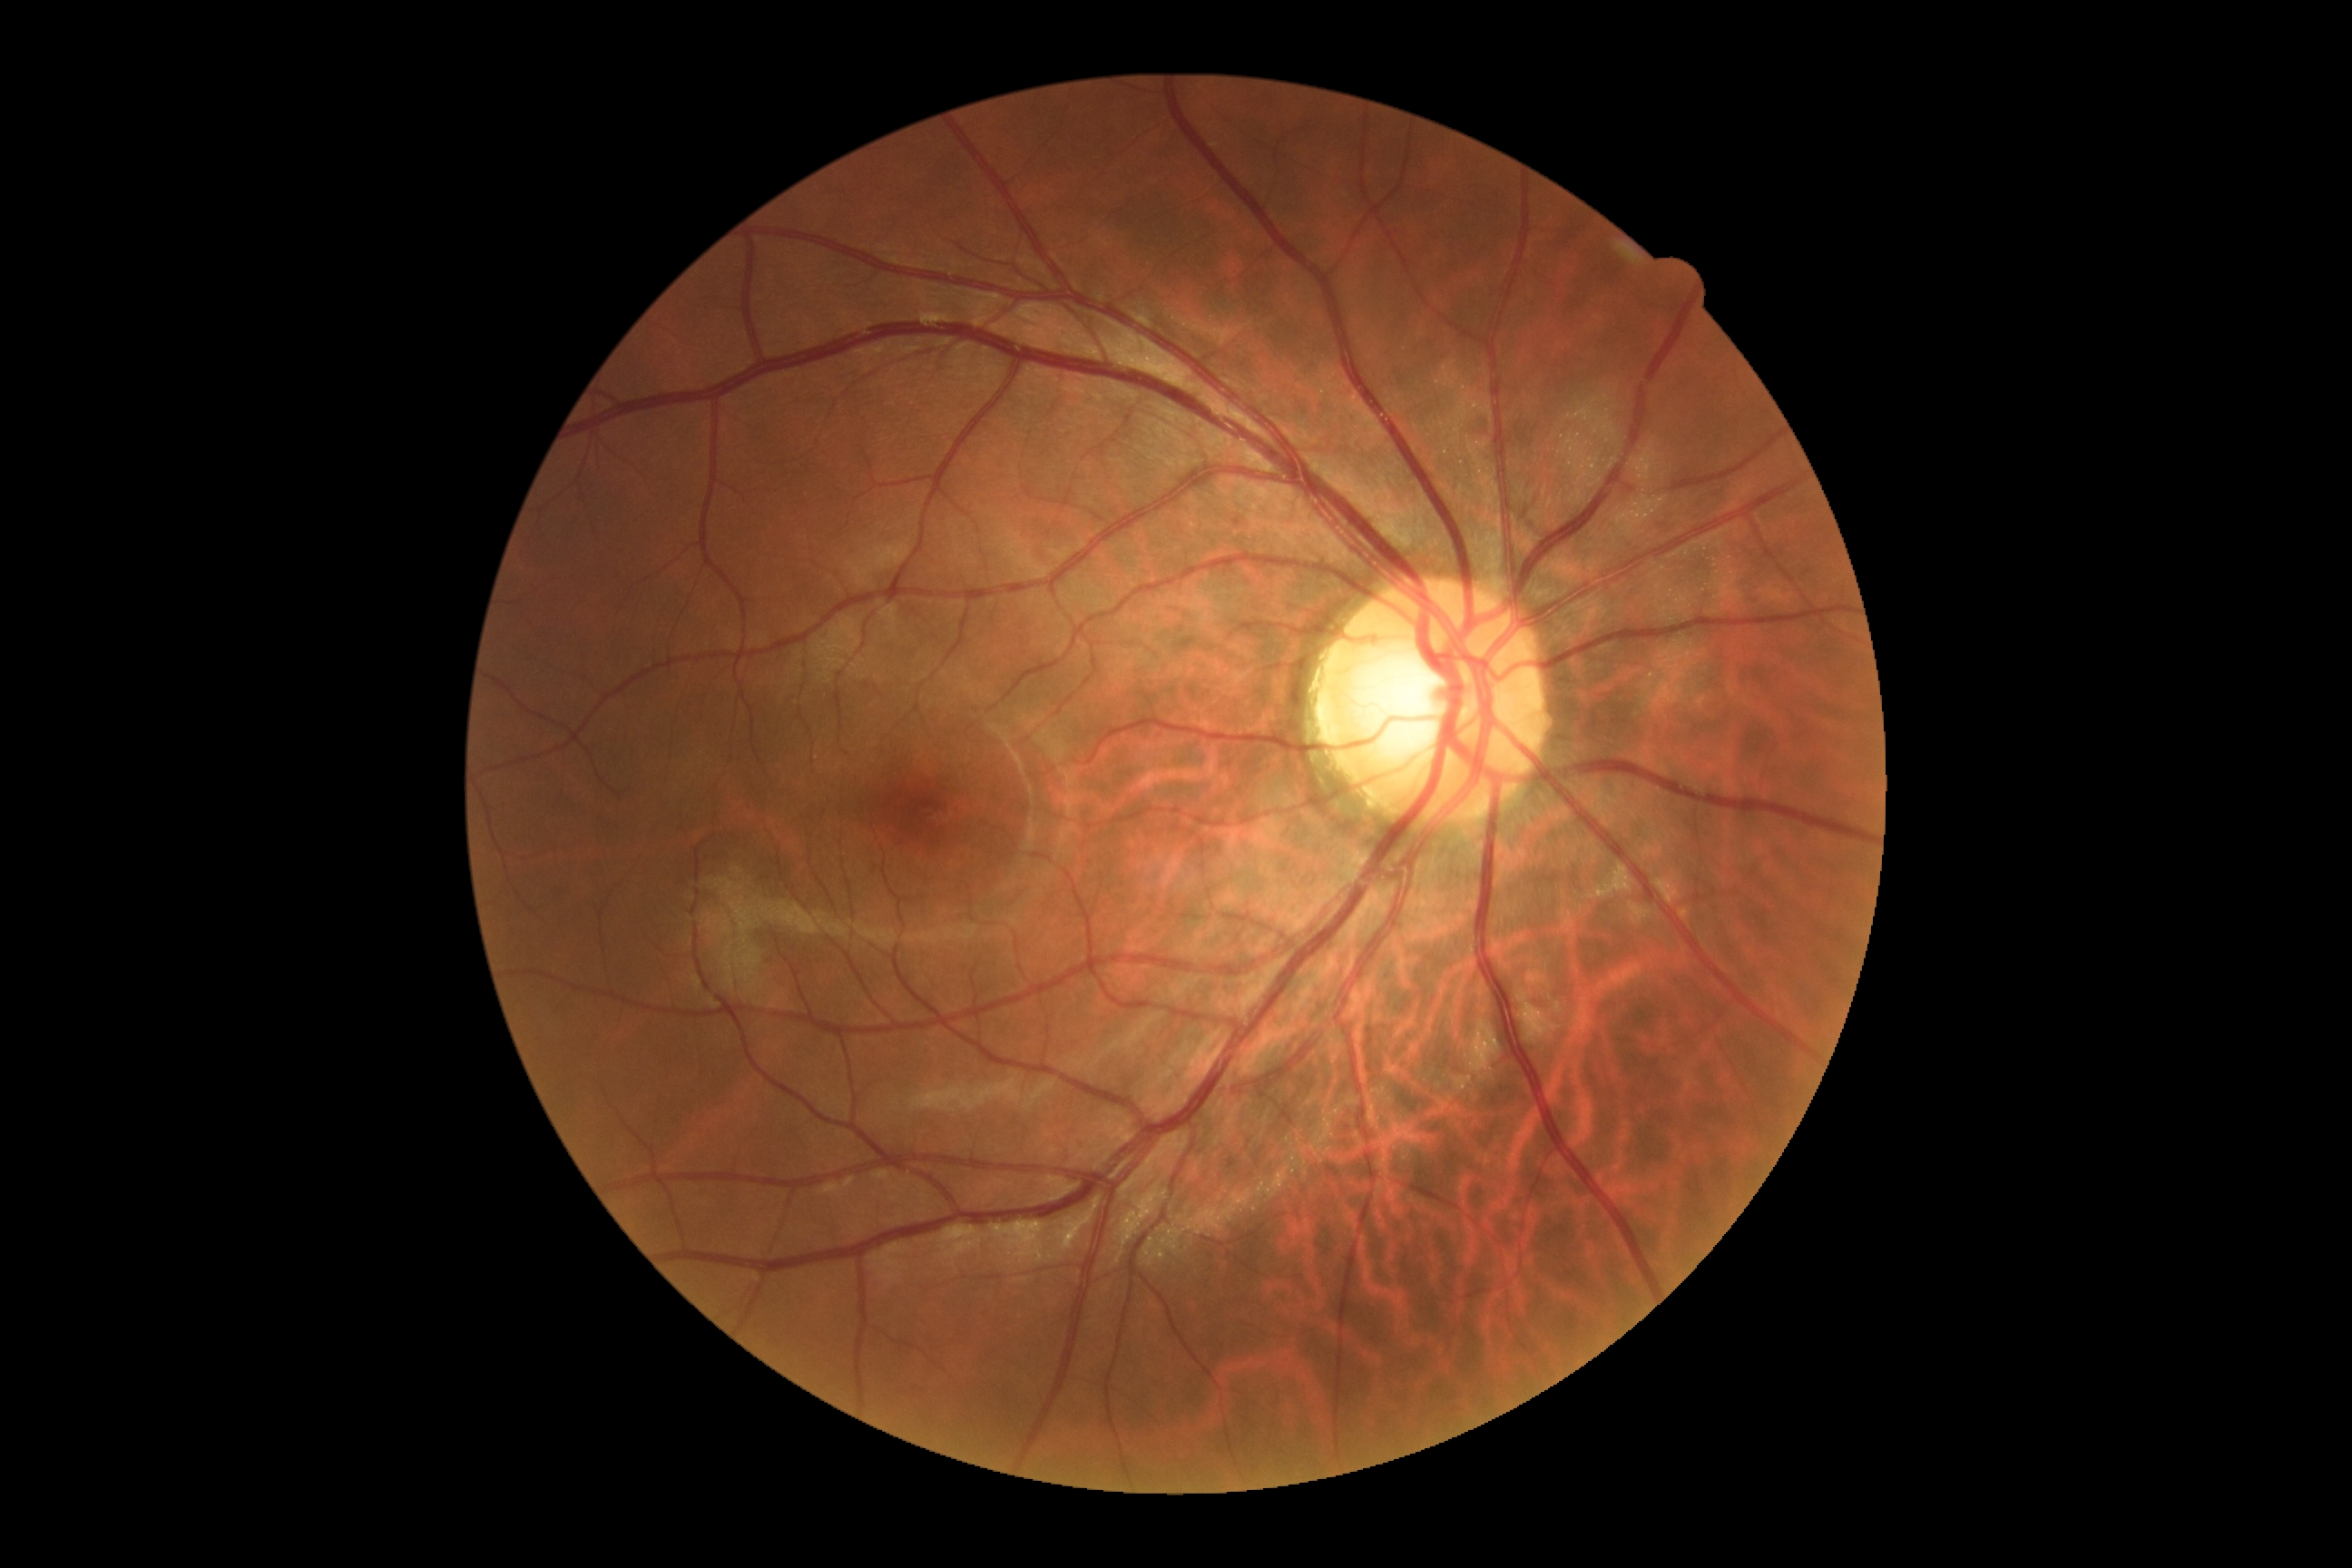 Retinopathy grade is 0 (no apparent retinopathy).